2212 x 1659 pixels; fundus photo; 45-degree field of view.
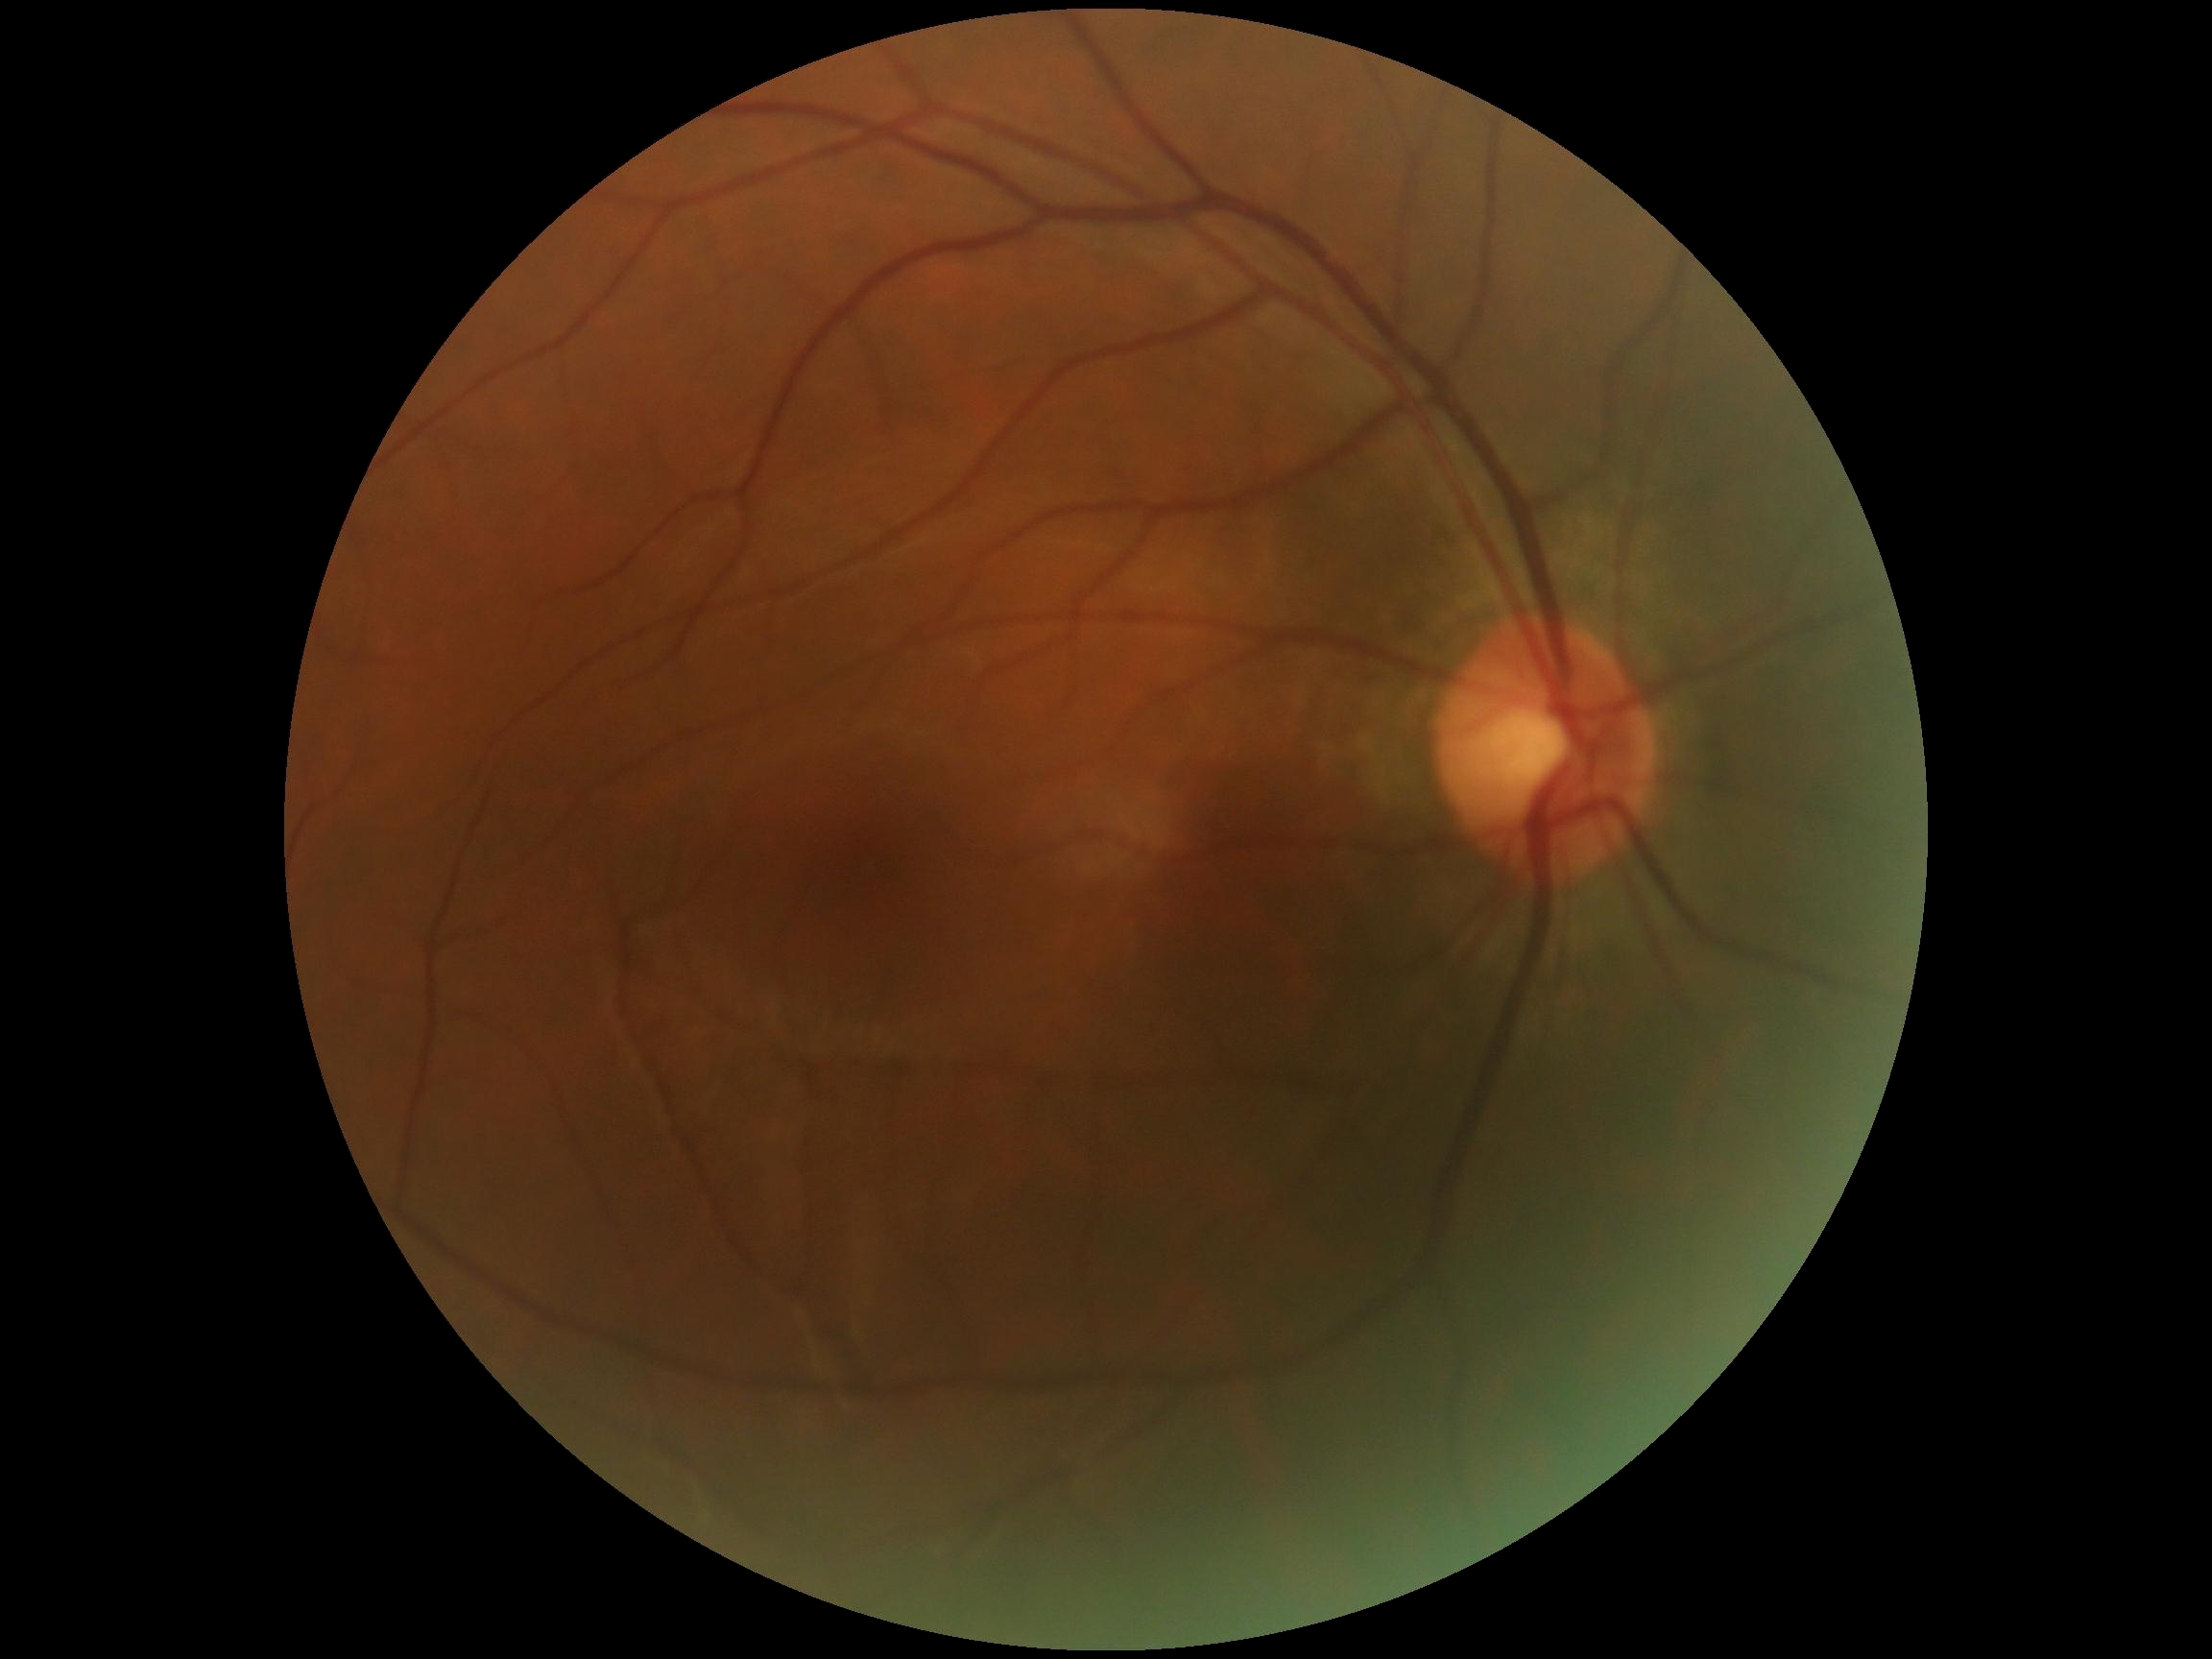

  dr_impression: no signs of DR
  dr_grade: no apparent retinopathy (0)